Disc-centered field
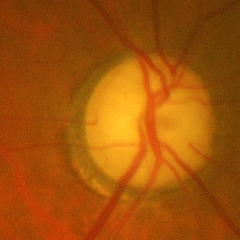

There is evidence of advanced glaucoma.